Camera: NIDEK AFC-230, 848x848px, diabetic retinopathy graded by the modified Davis classification
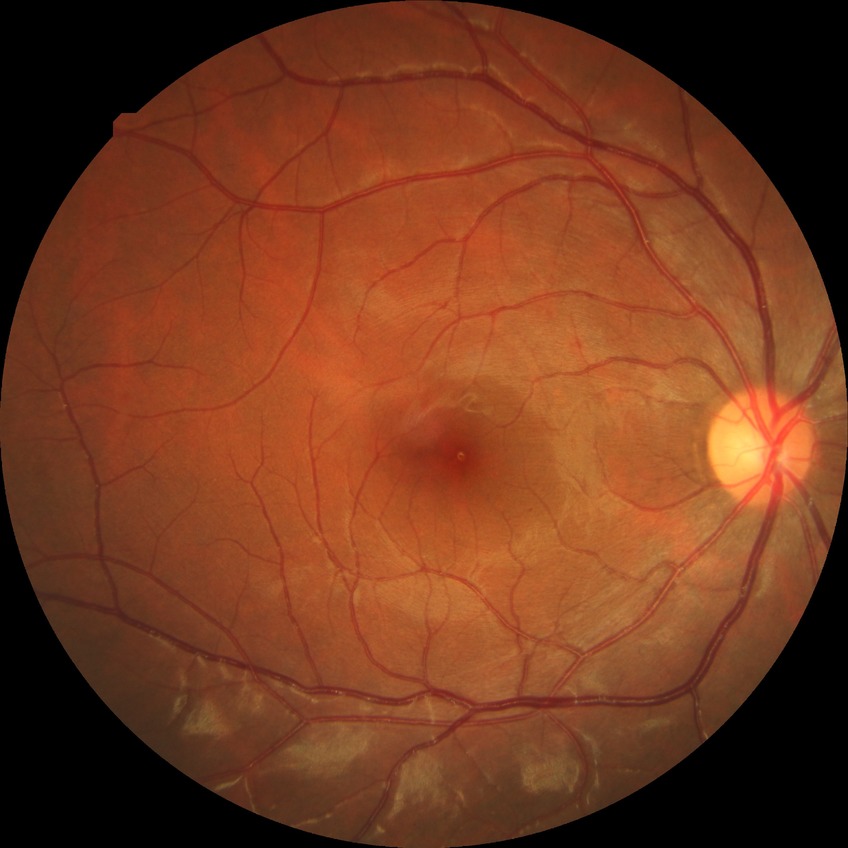 Diabetic retinopathy grade: no diabetic retinopathy.